1932x1932px. 45° field of view.
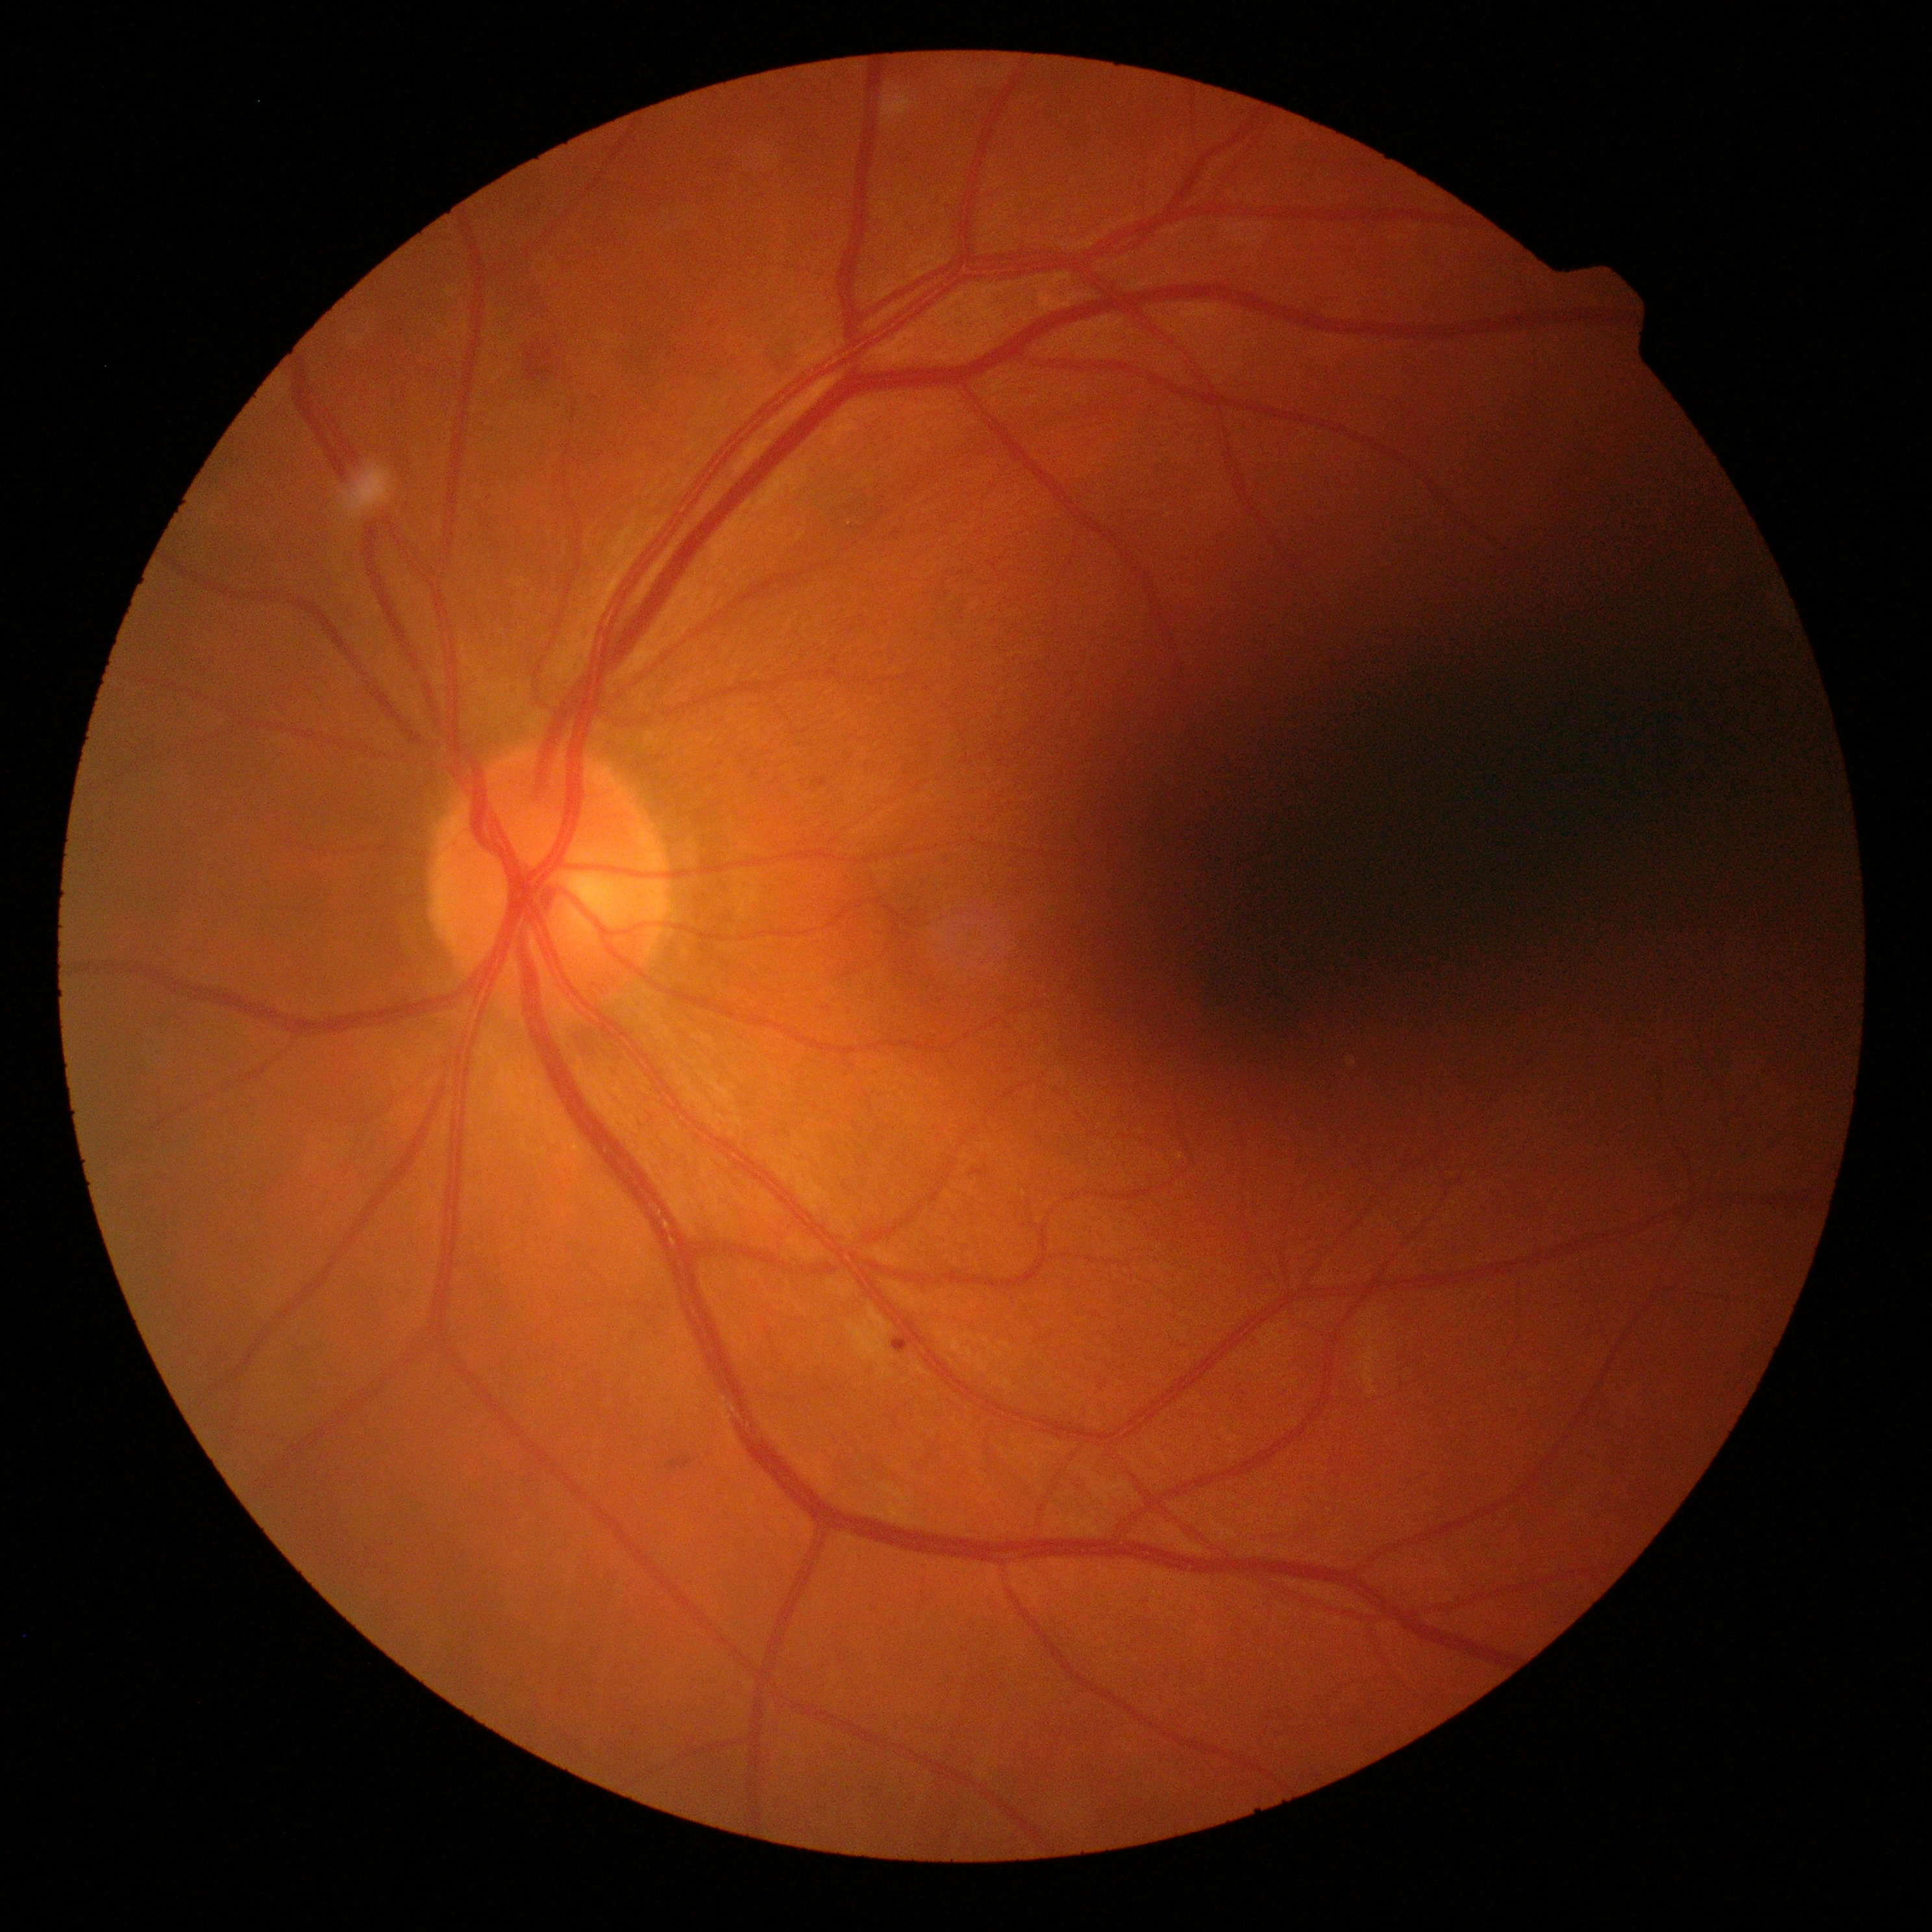
Diabetic retinopathy severity is moderate NPDR (grade 2).